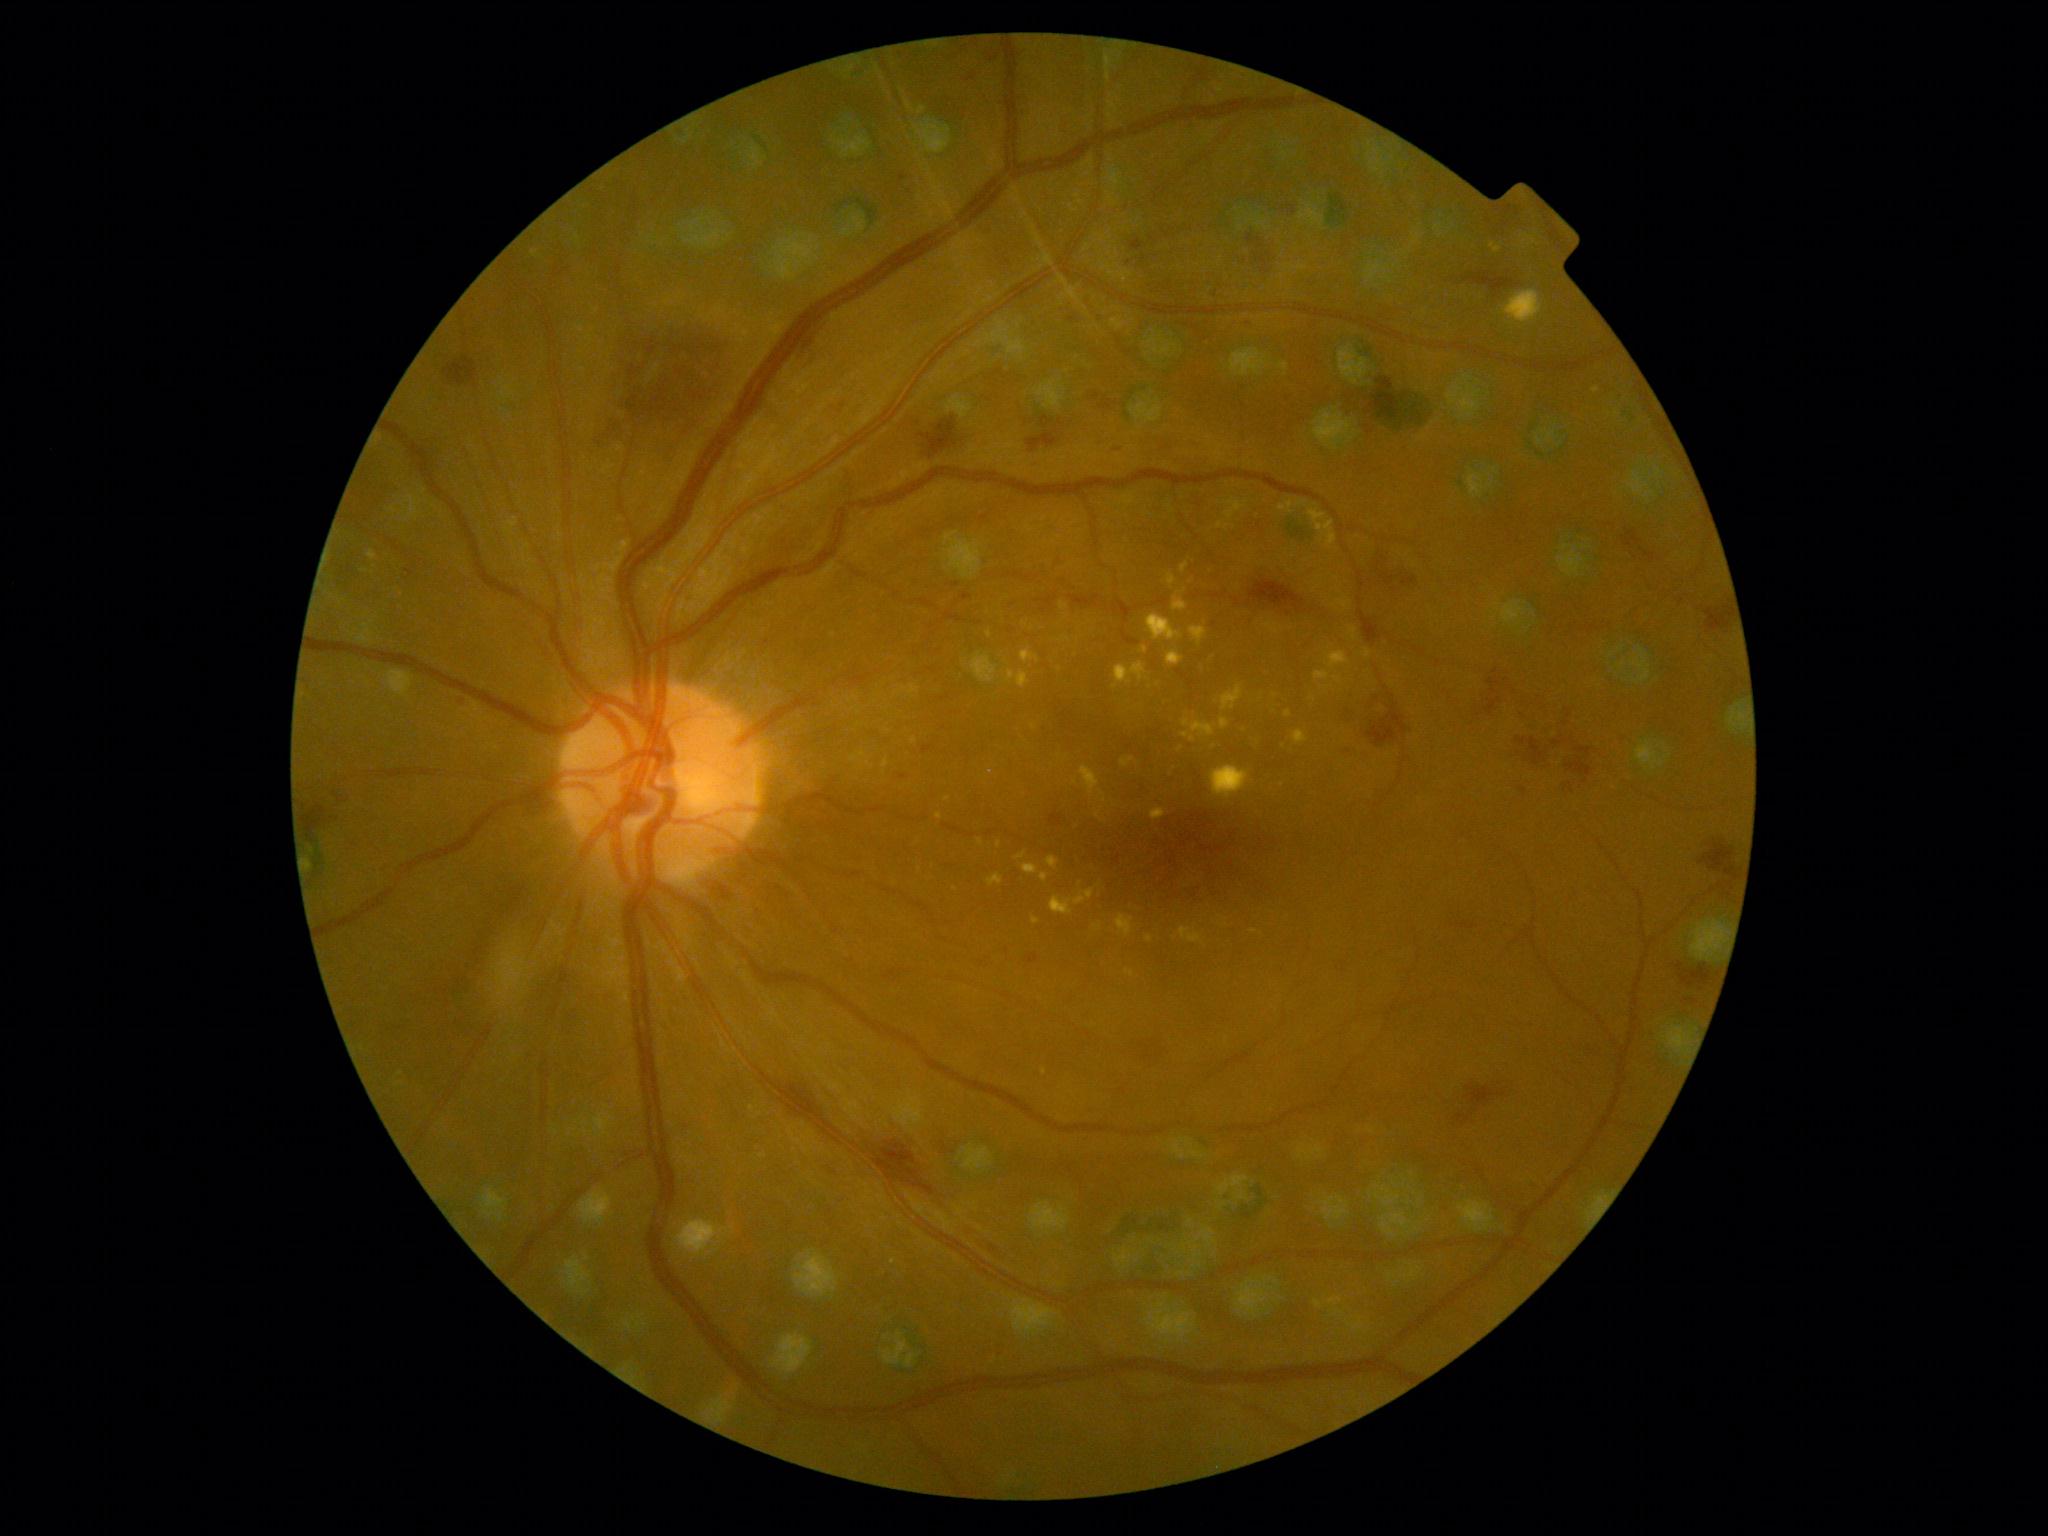

Retinopathy grade is 2 — more than just microaneurysms but less than severe NPDR
Lesions identified (partial list):
microaneurysms: none detected
soft exudates: none detected
hard exudates (continued): {"left": 1122, "top": 757, "right": 1135, "bottom": 768} | {"left": 1182, "top": 719, "right": 1215, "bottom": 736} | {"left": 987, "top": 874, "right": 1003, "bottom": 886} | {"left": 1221, "top": 719, "right": 1229, "bottom": 730} | {"left": 1047, "top": 856, "right": 1059, "bottom": 871} | {"left": 1050, "top": 889, "right": 1095, "bottom": 915} | {"left": 1334, "top": 677, "right": 1343, "bottom": 685} | {"left": 1298, "top": 501, "right": 1307, "bottom": 507} | {"left": 1179, "top": 928, "right": 1205, "bottom": 945} | {"left": 1166, "top": 651, "right": 1185, "bottom": 666} | {"left": 1503, "top": 291, "right": 1543, "bottom": 324} | {"left": 1115, "top": 662, "right": 1146, "bottom": 689} | {"left": 368, "top": 550, "right": 377, "bottom": 561} | {"left": 1292, "top": 730, "right": 1308, "bottom": 745}
Additional small hard exudates near x=1254, y=931 | x=939, y=816 | x=1098, y=927 | x=947, y=800
hemorrhages (continued): {"left": 1370, "top": 544, "right": 1388, "bottom": 570} | {"left": 1576, "top": 747, "right": 1592, "bottom": 756} | {"left": 963, "top": 593, "right": 971, "bottom": 601} | {"left": 1476, "top": 669, "right": 1500, "bottom": 720} | {"left": 1242, "top": 319, "right": 1258, "bottom": 331} | {"left": 1516, "top": 737, "right": 1527, "bottom": 746} | {"left": 1516, "top": 749, "right": 1529, "bottom": 762} | {"left": 1699, "top": 843, "right": 1741, "bottom": 881} | {"left": 1099, "top": 398, "right": 1112, "bottom": 410} | {"left": 301, "top": 806, "right": 327, "bottom": 842} | {"left": 589, "top": 318, "right": 737, "bottom": 461} | {"left": 1679, "top": 966, "right": 1712, "bottom": 988} | {"left": 1456, "top": 1085, "right": 1507, "bottom": 1125} | {"left": 1462, "top": 924, "right": 1477, "bottom": 929}
Additional small hemorrhages near x=903, y=777 | x=1144, y=258